Color fundus image · 50° field of view:
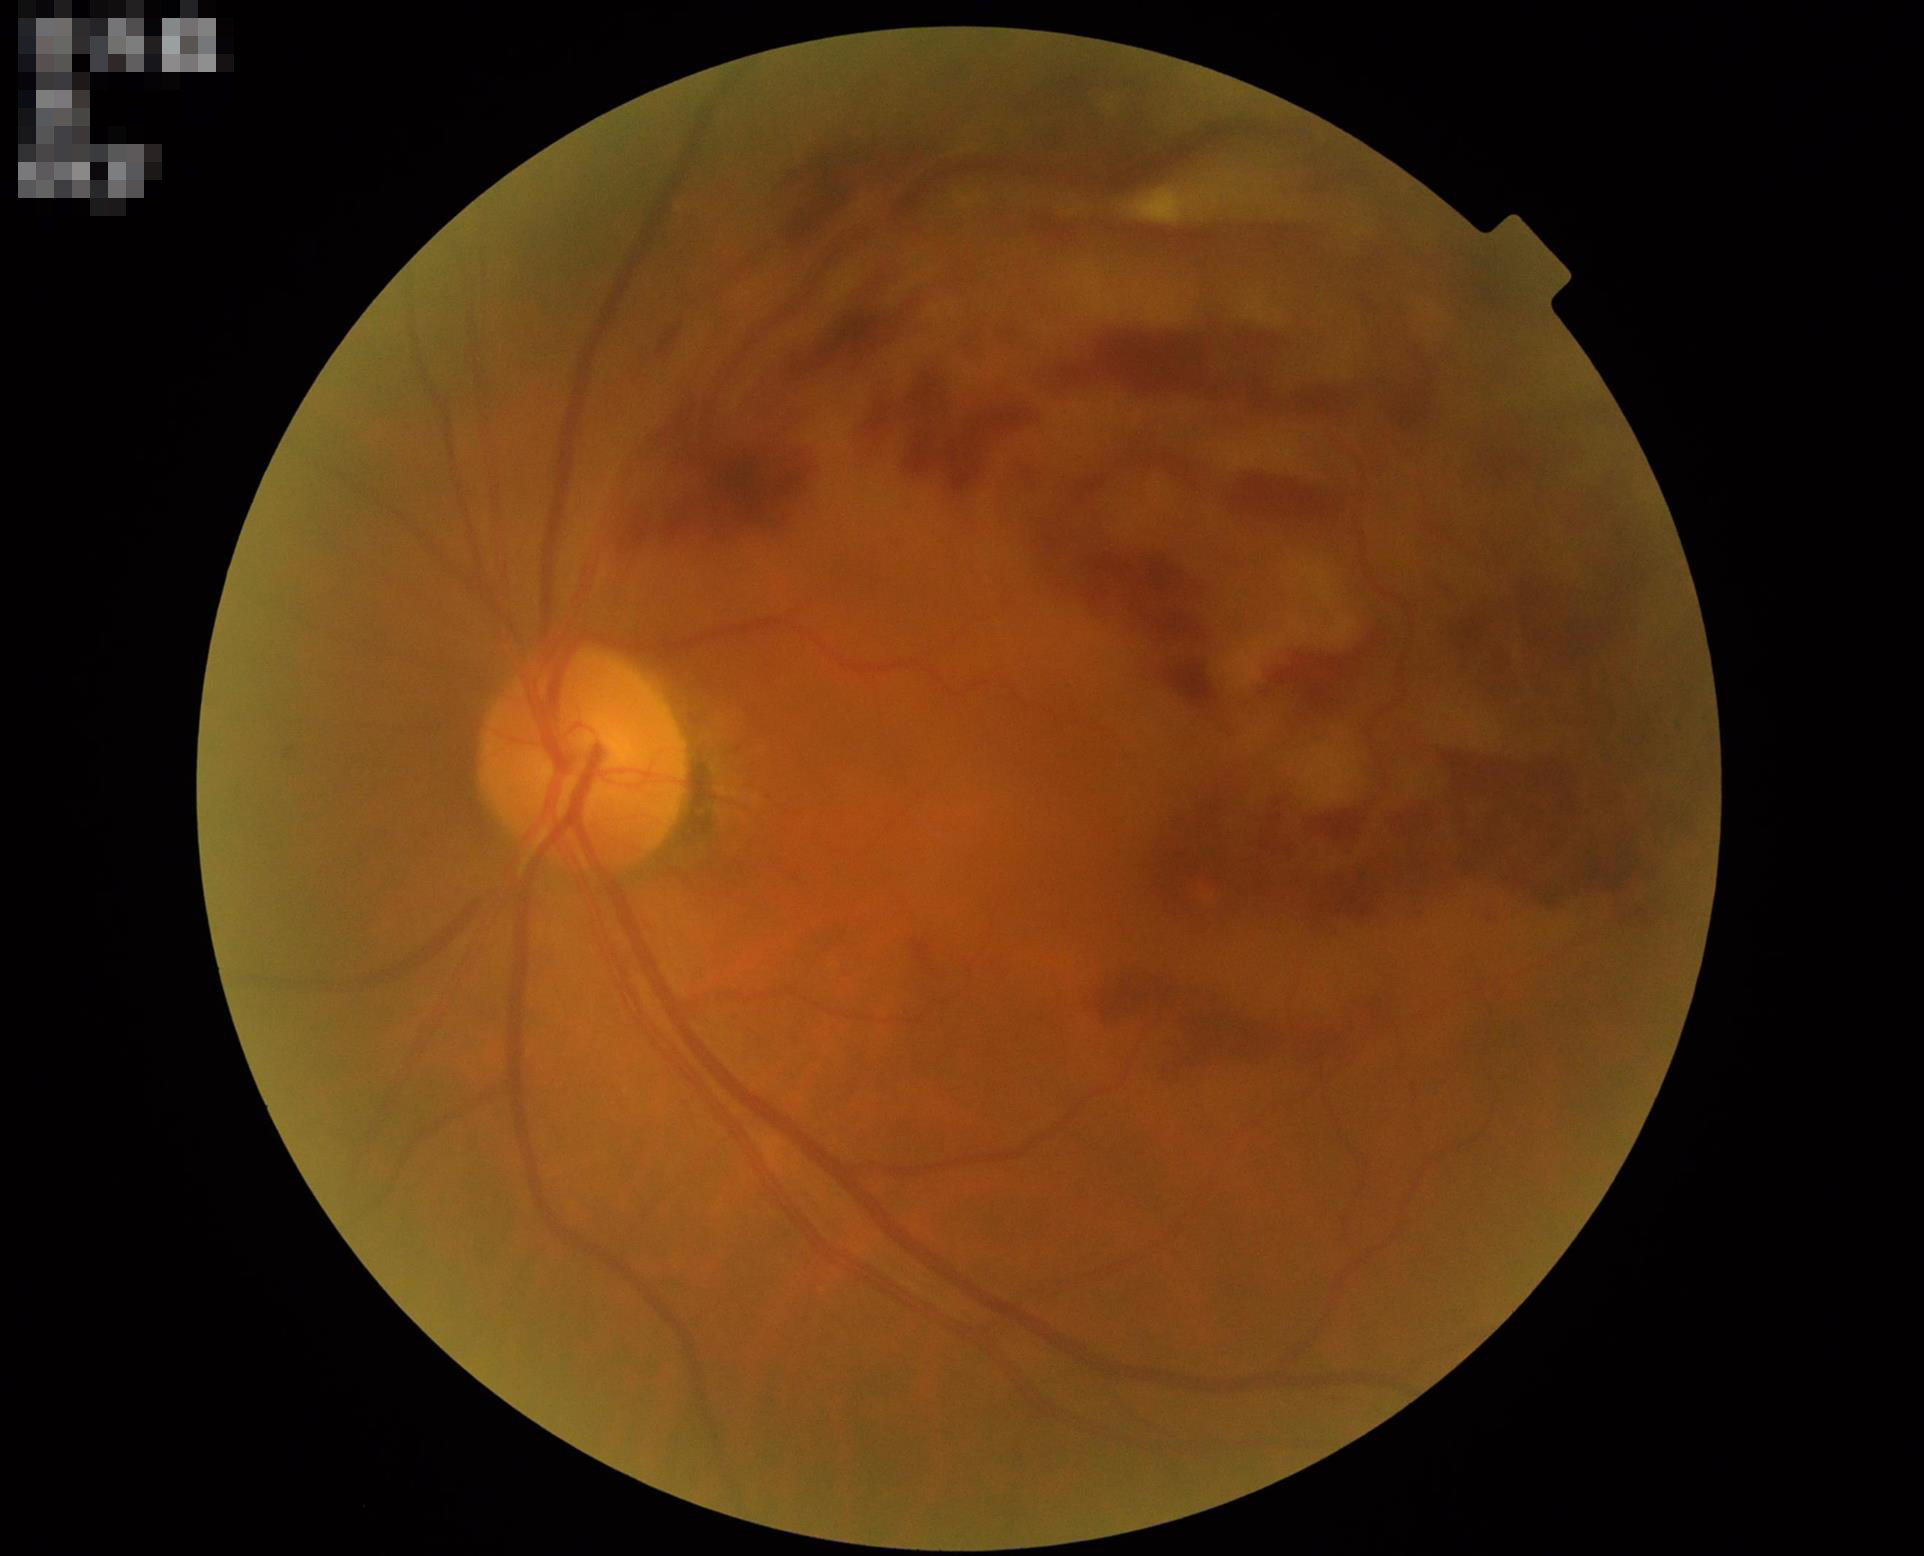

Even illumination with no color cast.
Good dynamic range.
Overall quality is poor; the image is difficult to grade.
Reduced sharpness with visible blur.